2352x1568; retinal fundus photograph
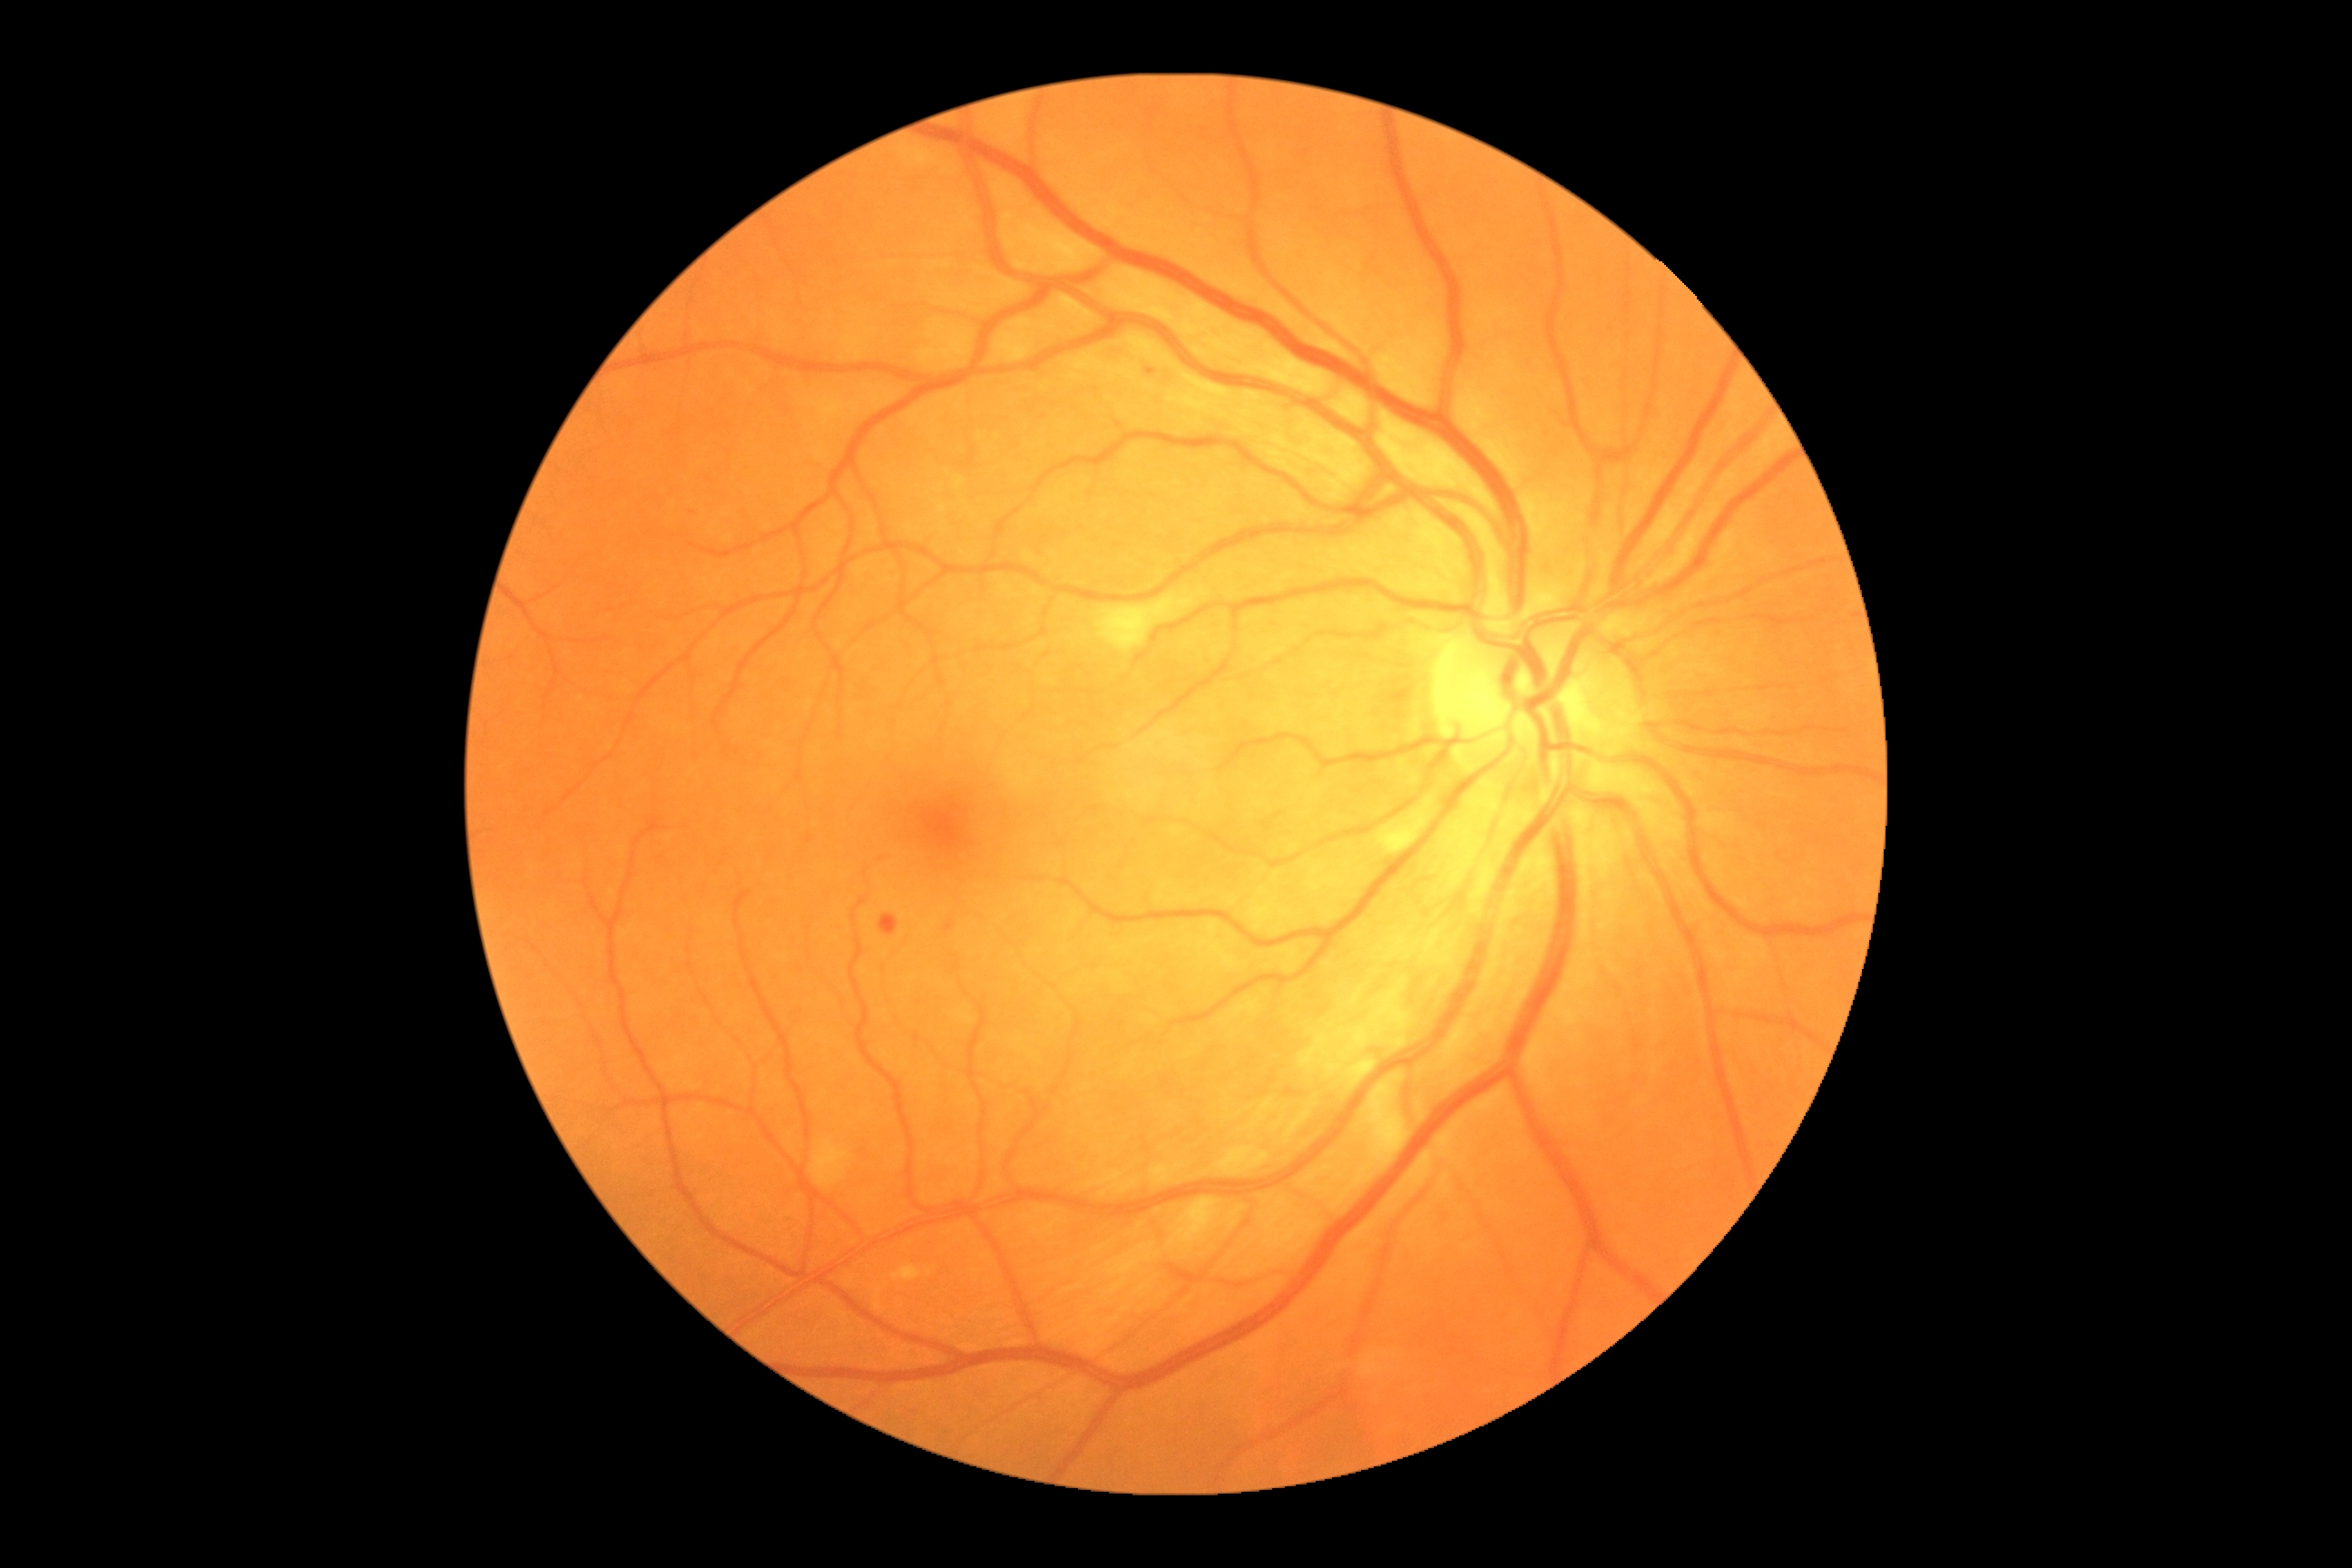

diabetic retinopathy (DR) = 2/4 — more than just microaneurysms but less than severe NPDR.